RetCam wide-field infant fundus image.
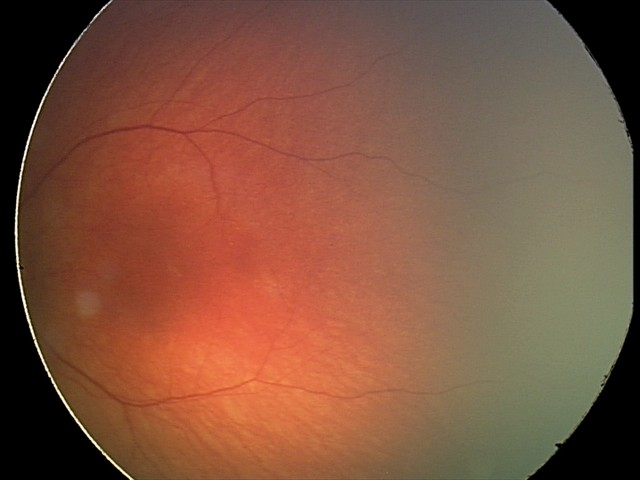
Impression = no abnormalities.